2361x1568. Retinal fundus photograph. 45° field of view:
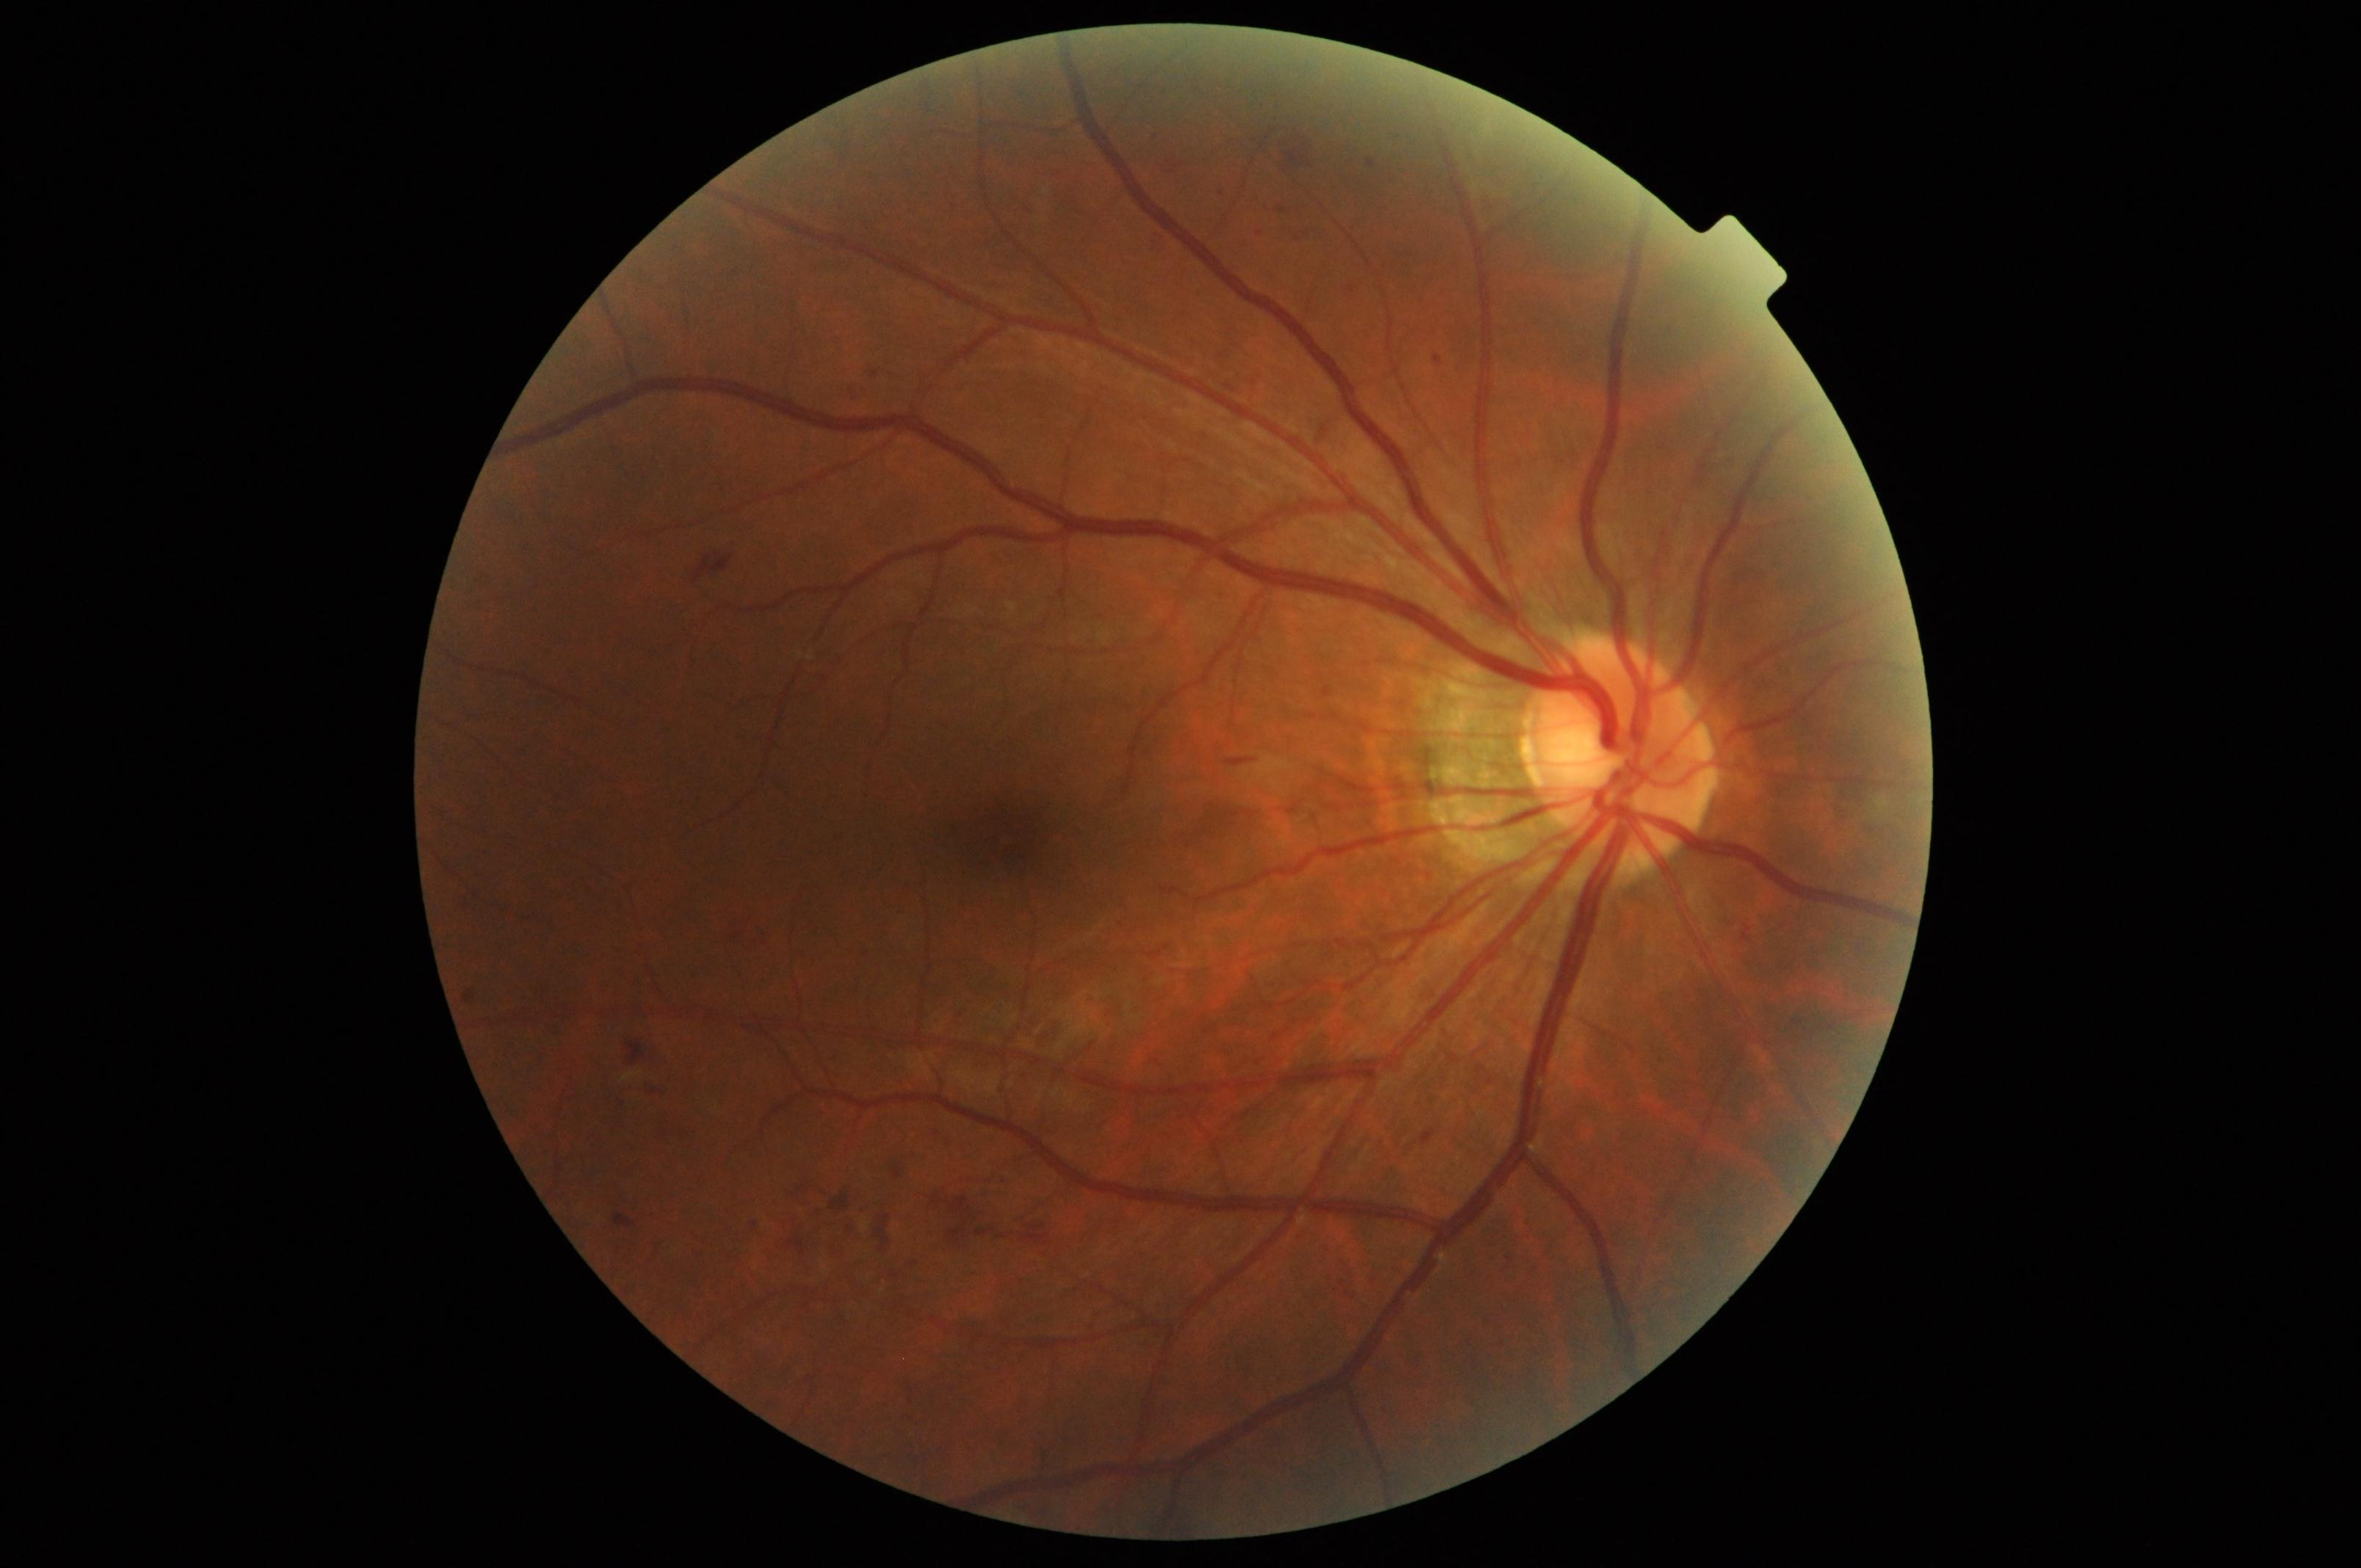
{
  "dr_grade": "moderate NPDR (grade 2)"
}